45° FOV; 2212 by 1659 pixels; CFP.
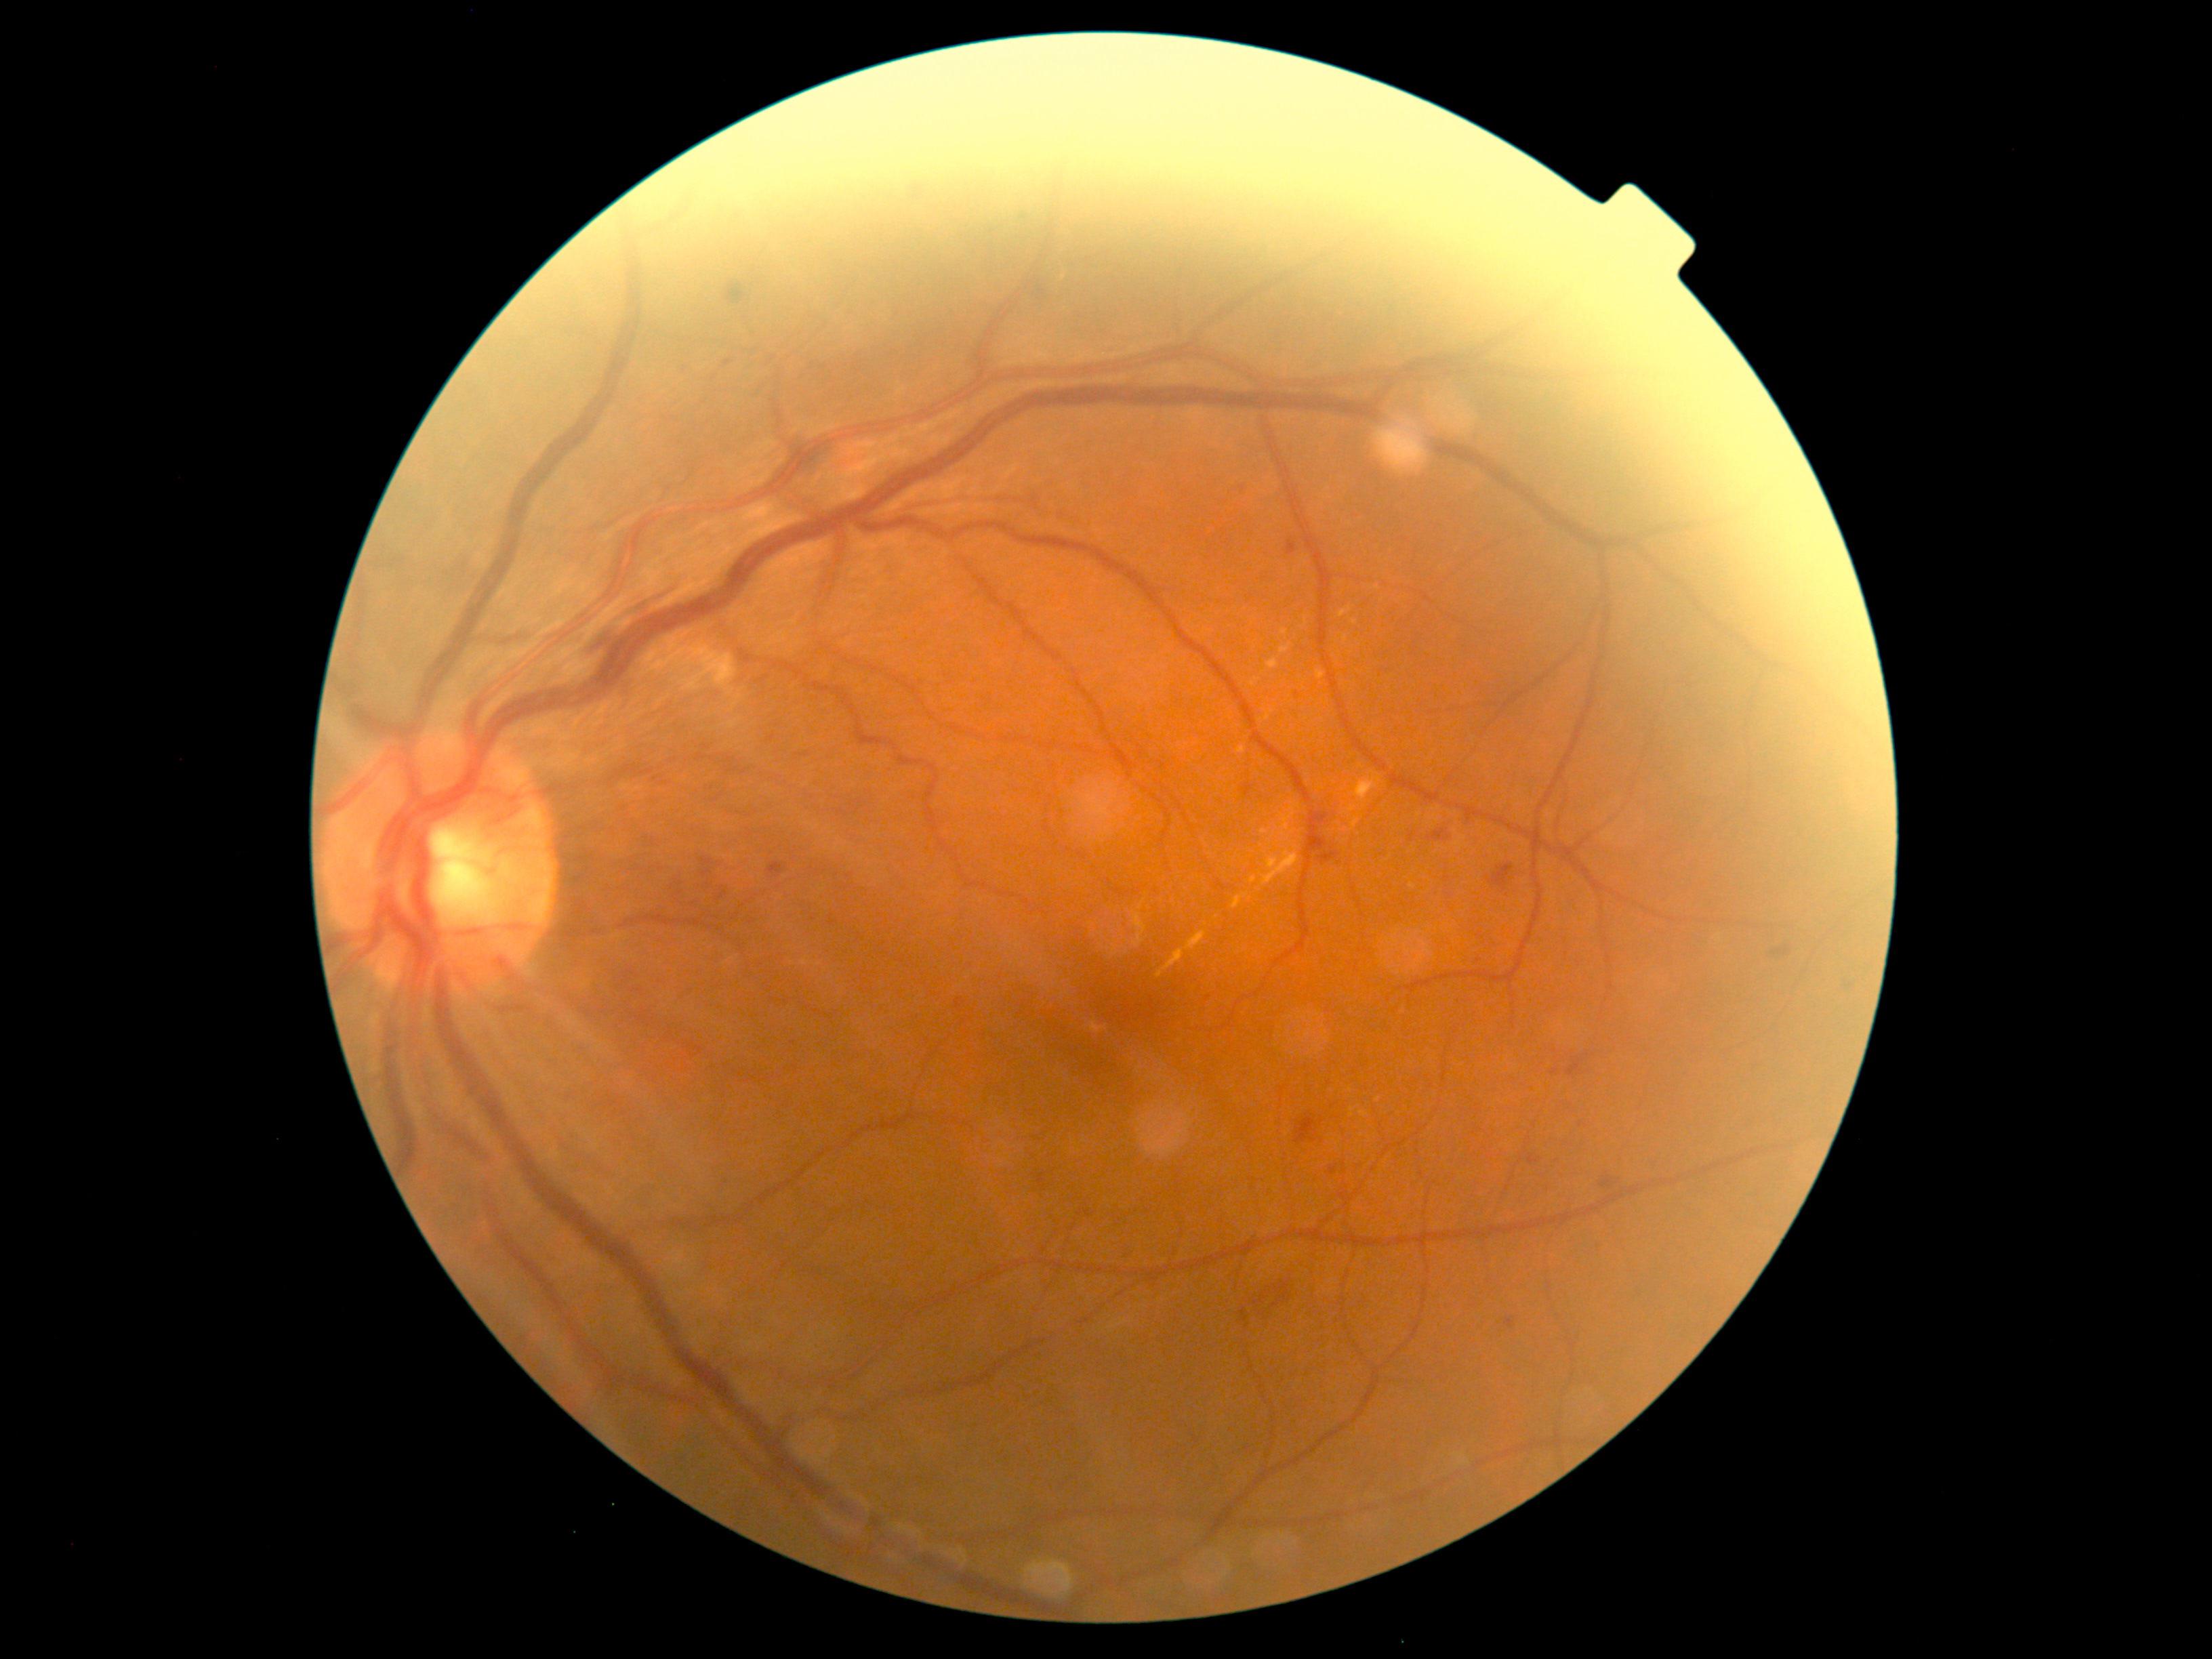
Diabetic retinopathy: grade 2 (moderate NPDR)
Selected lesions:
hemorrhages: left=700, top=853, right=715, bottom=890 | left=1295, top=1113, right=1318, bottom=1145 | left=1272, top=1280, right=1292, bottom=1309 | left=1039, top=285, right=1051, bottom=311 | left=1568, top=1059, right=1582, bottom=1077 | left=1427, top=829, right=1451, bottom=841 | left=1318, top=851, right=1340, bottom=864 | left=585, top=583, right=677, bottom=657 | left=1319, top=815, right=1334, bottom=832 | left=1254, top=1292, right=1271, bottom=1306 | left=1489, top=864, right=1515, bottom=891 | left=1315, top=840, right=1325, bottom=856 | left=1601, top=1179, right=1615, bottom=1189 | left=727, top=284, right=746, bottom=304
hard exudates (more not shown): left=1136, top=913, right=1147, bottom=948 | left=1139, top=902, right=1145, bottom=912 | left=1317, top=670, right=1326, bottom=680 | left=1338, top=607, right=1352, bottom=617 | left=1353, top=772, right=1382, bottom=803 | left=1157, top=932, right=1207, bottom=978 | left=1237, top=746, right=1246, bottom=754 | left=1279, top=643, right=1292, bottom=655
Additional small hard exudates near (x=1345, y=638) | (x=1353, y=1110) | (x=1264, y=832)
microaneurysms: left=768, top=863, right=785, bottom=878 | left=1551, top=1070, right=1559, bottom=1074 | left=724, top=360, right=734, bottom=368 | left=1287, top=539, right=1296, bottom=555 | left=955, top=998, right=966, bottom=1009 | left=1505, top=1318, right=1515, bottom=1329 | left=1528, top=1155, right=1540, bottom=1165 | left=1328, top=1166, right=1337, bottom=1176
Additional small microaneurysms near (x=1243, y=488) | (x=1209, y=998) | (x=1297, y=695)
soft exudates: none